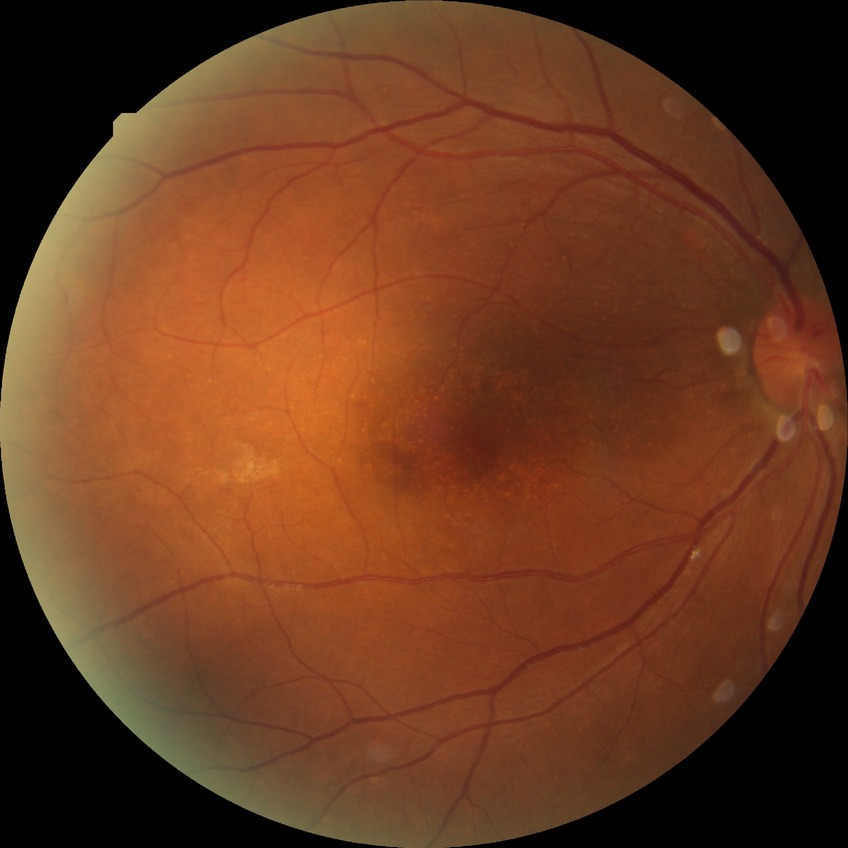
Diabetic retinopathy (DR): no diabetic retinopathy (NDR).